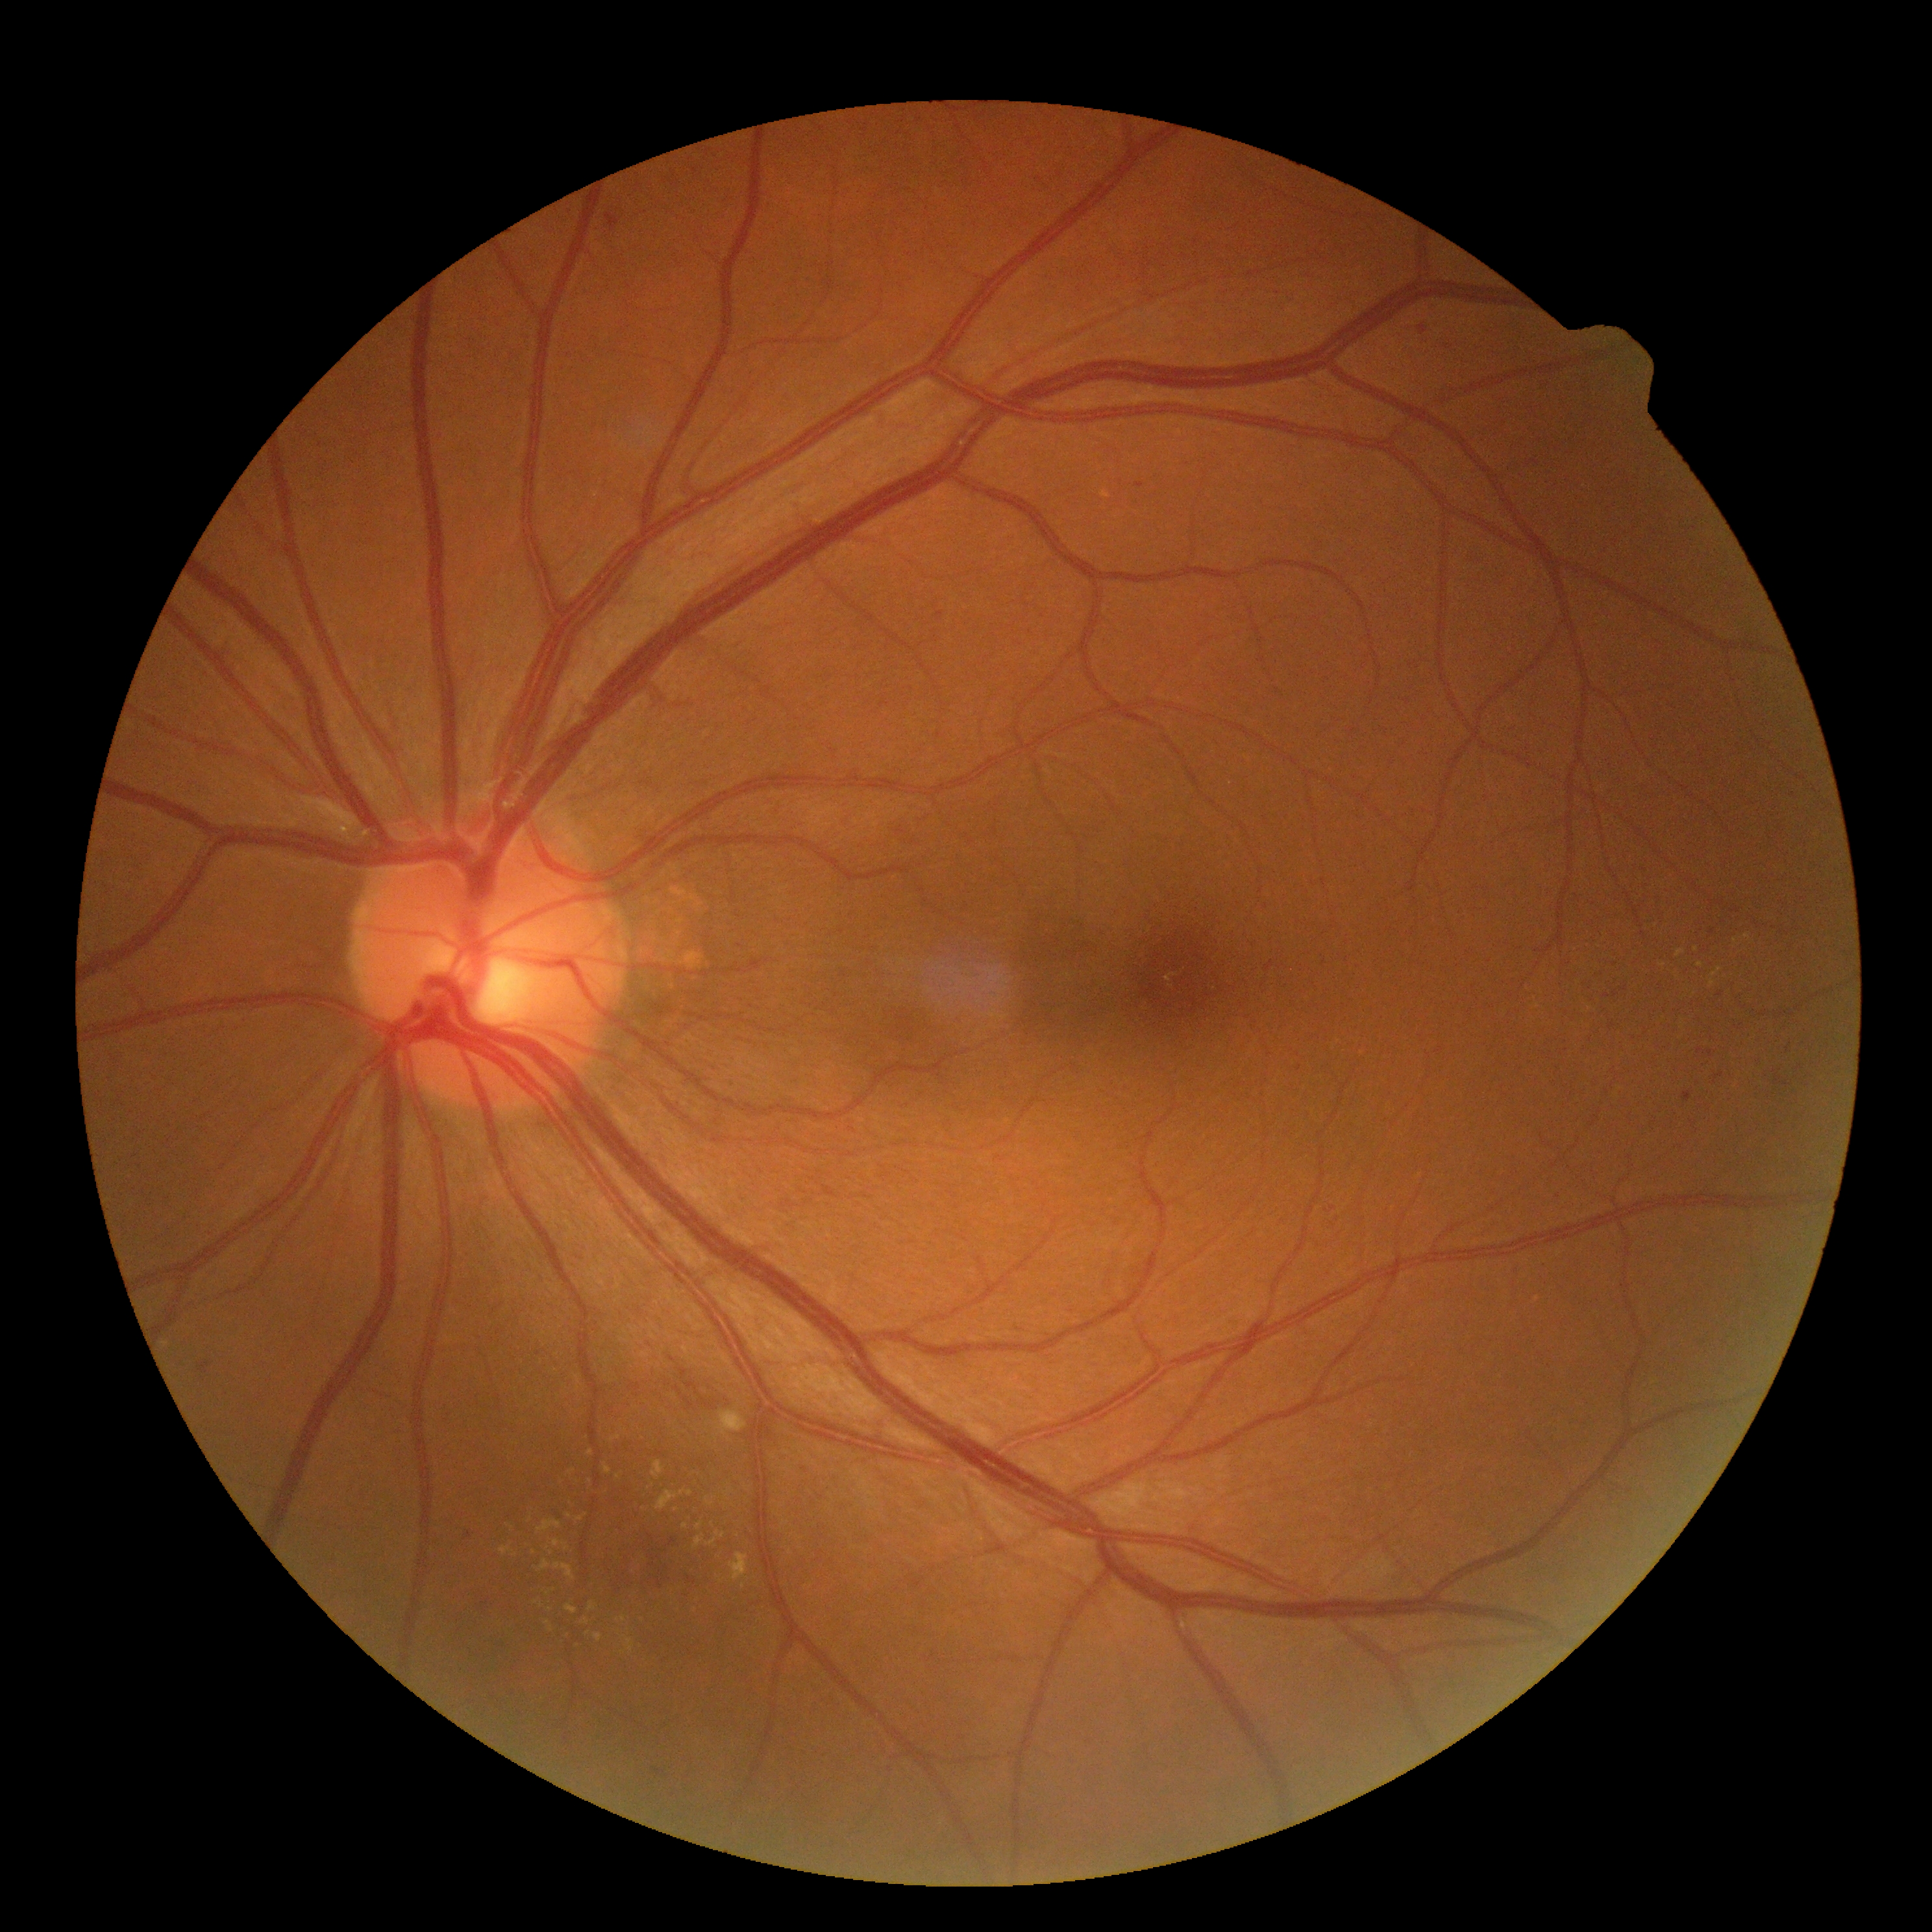

Findings:
- DR stage — moderate non-proliferative diabetic retinopathy (grade 2)